Wide-field fundus image from infant ROP screening. 640x480px. Acquired on the Clarity RetCam 3: 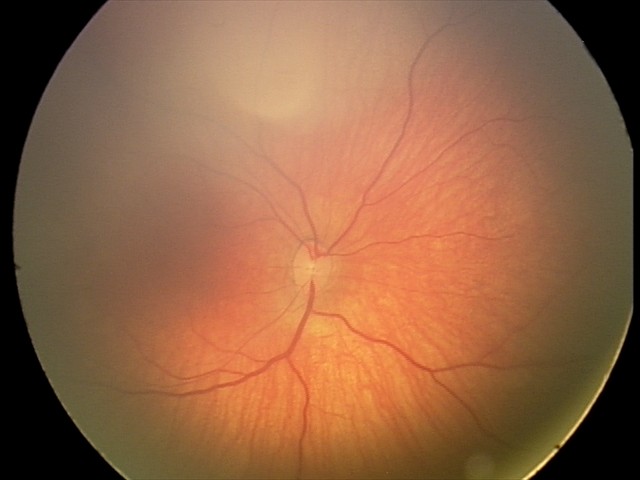
Series diagnosed as retinal hemorrhages.